Pediatric retinal photograph (wide-field) · 640x480px: 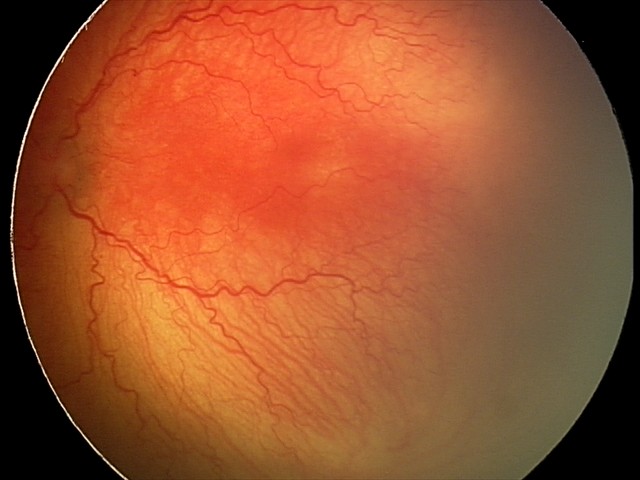 Diagnosis from this screening exam: aggressive ROP (A-ROP).
Plus disease present.